Wide-field fundus photograph from neonatal ROP screening. Camera: Clarity RetCam 3 (130° FOV).
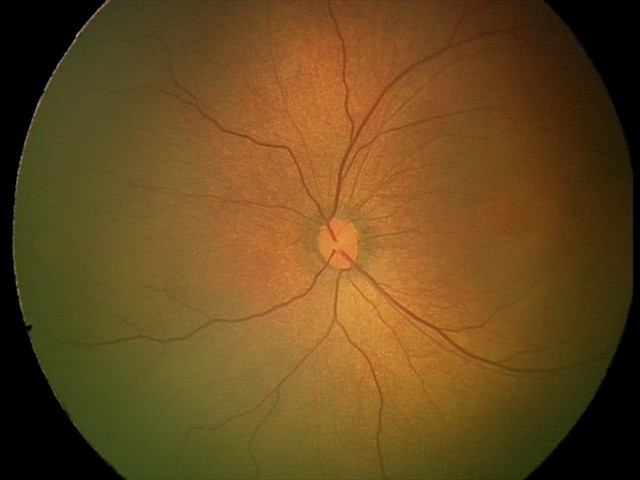
Assessment: physiological retinal finding.